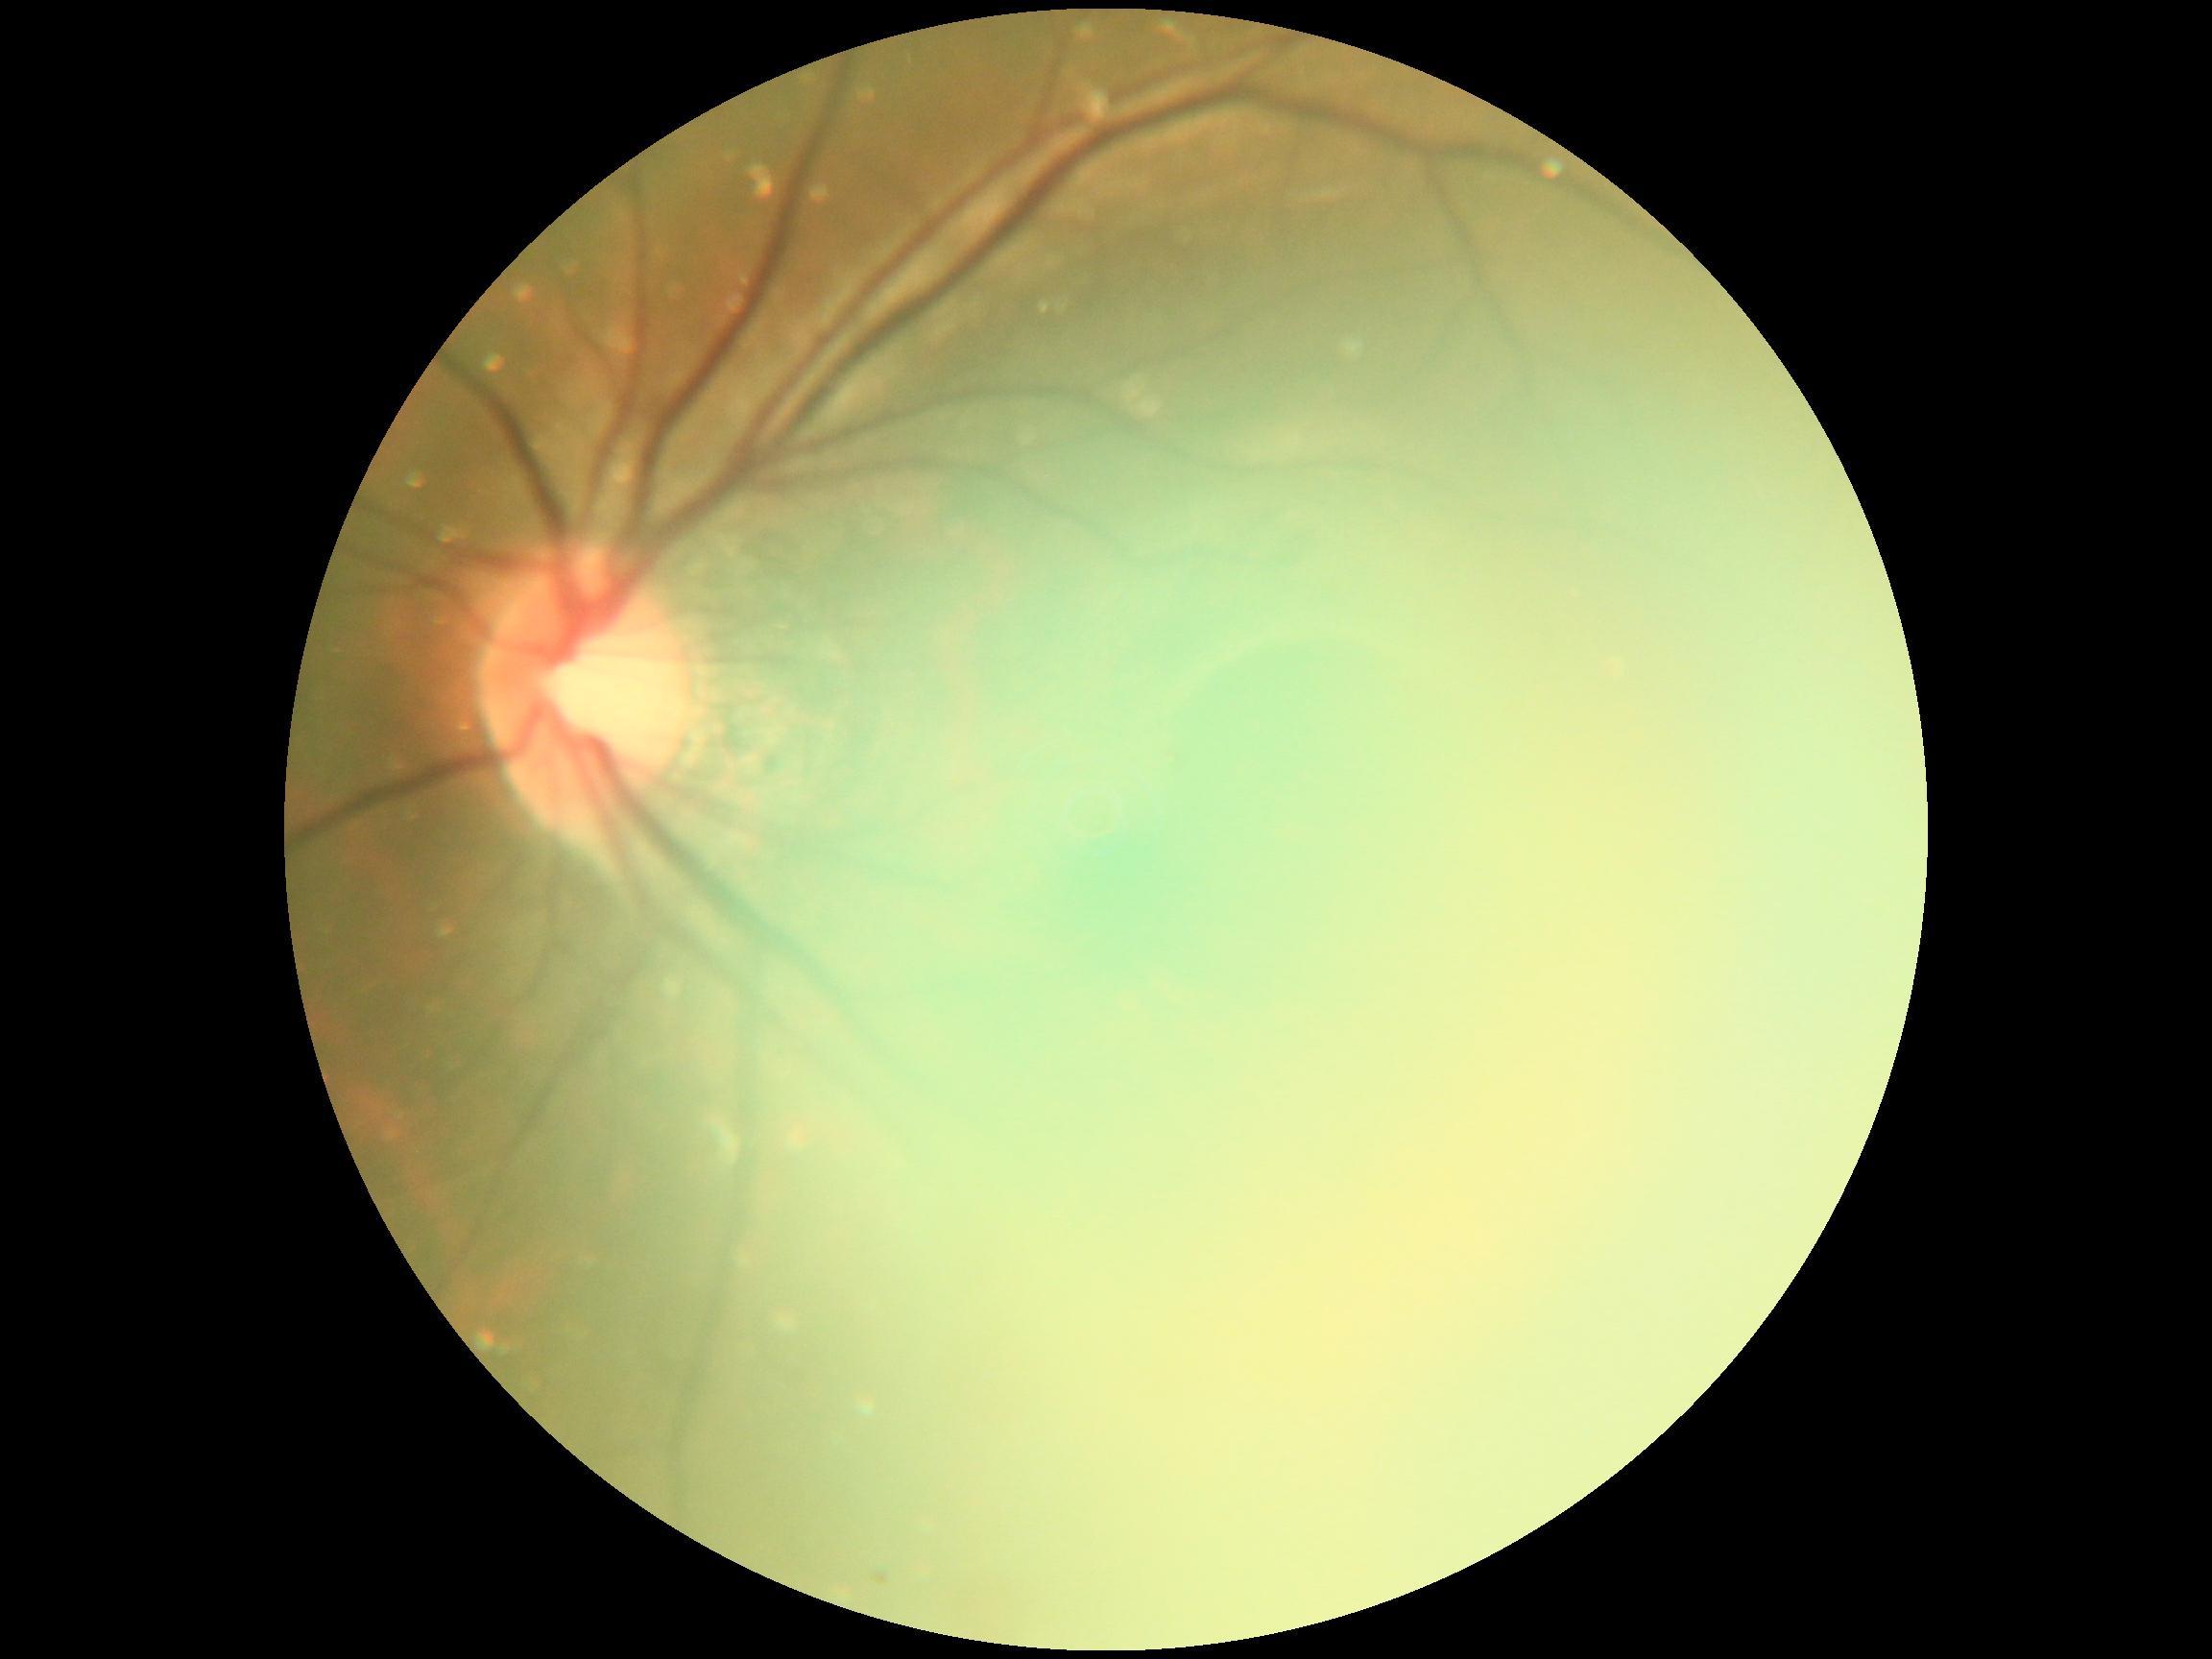 {"quality": "insufficient", "dr_grade": "ungradable due to poor image quality"}